240x240px — 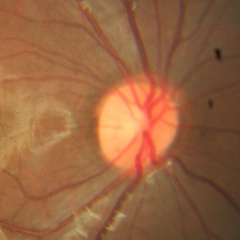 No glaucomatous findings.